45-degree field of view — 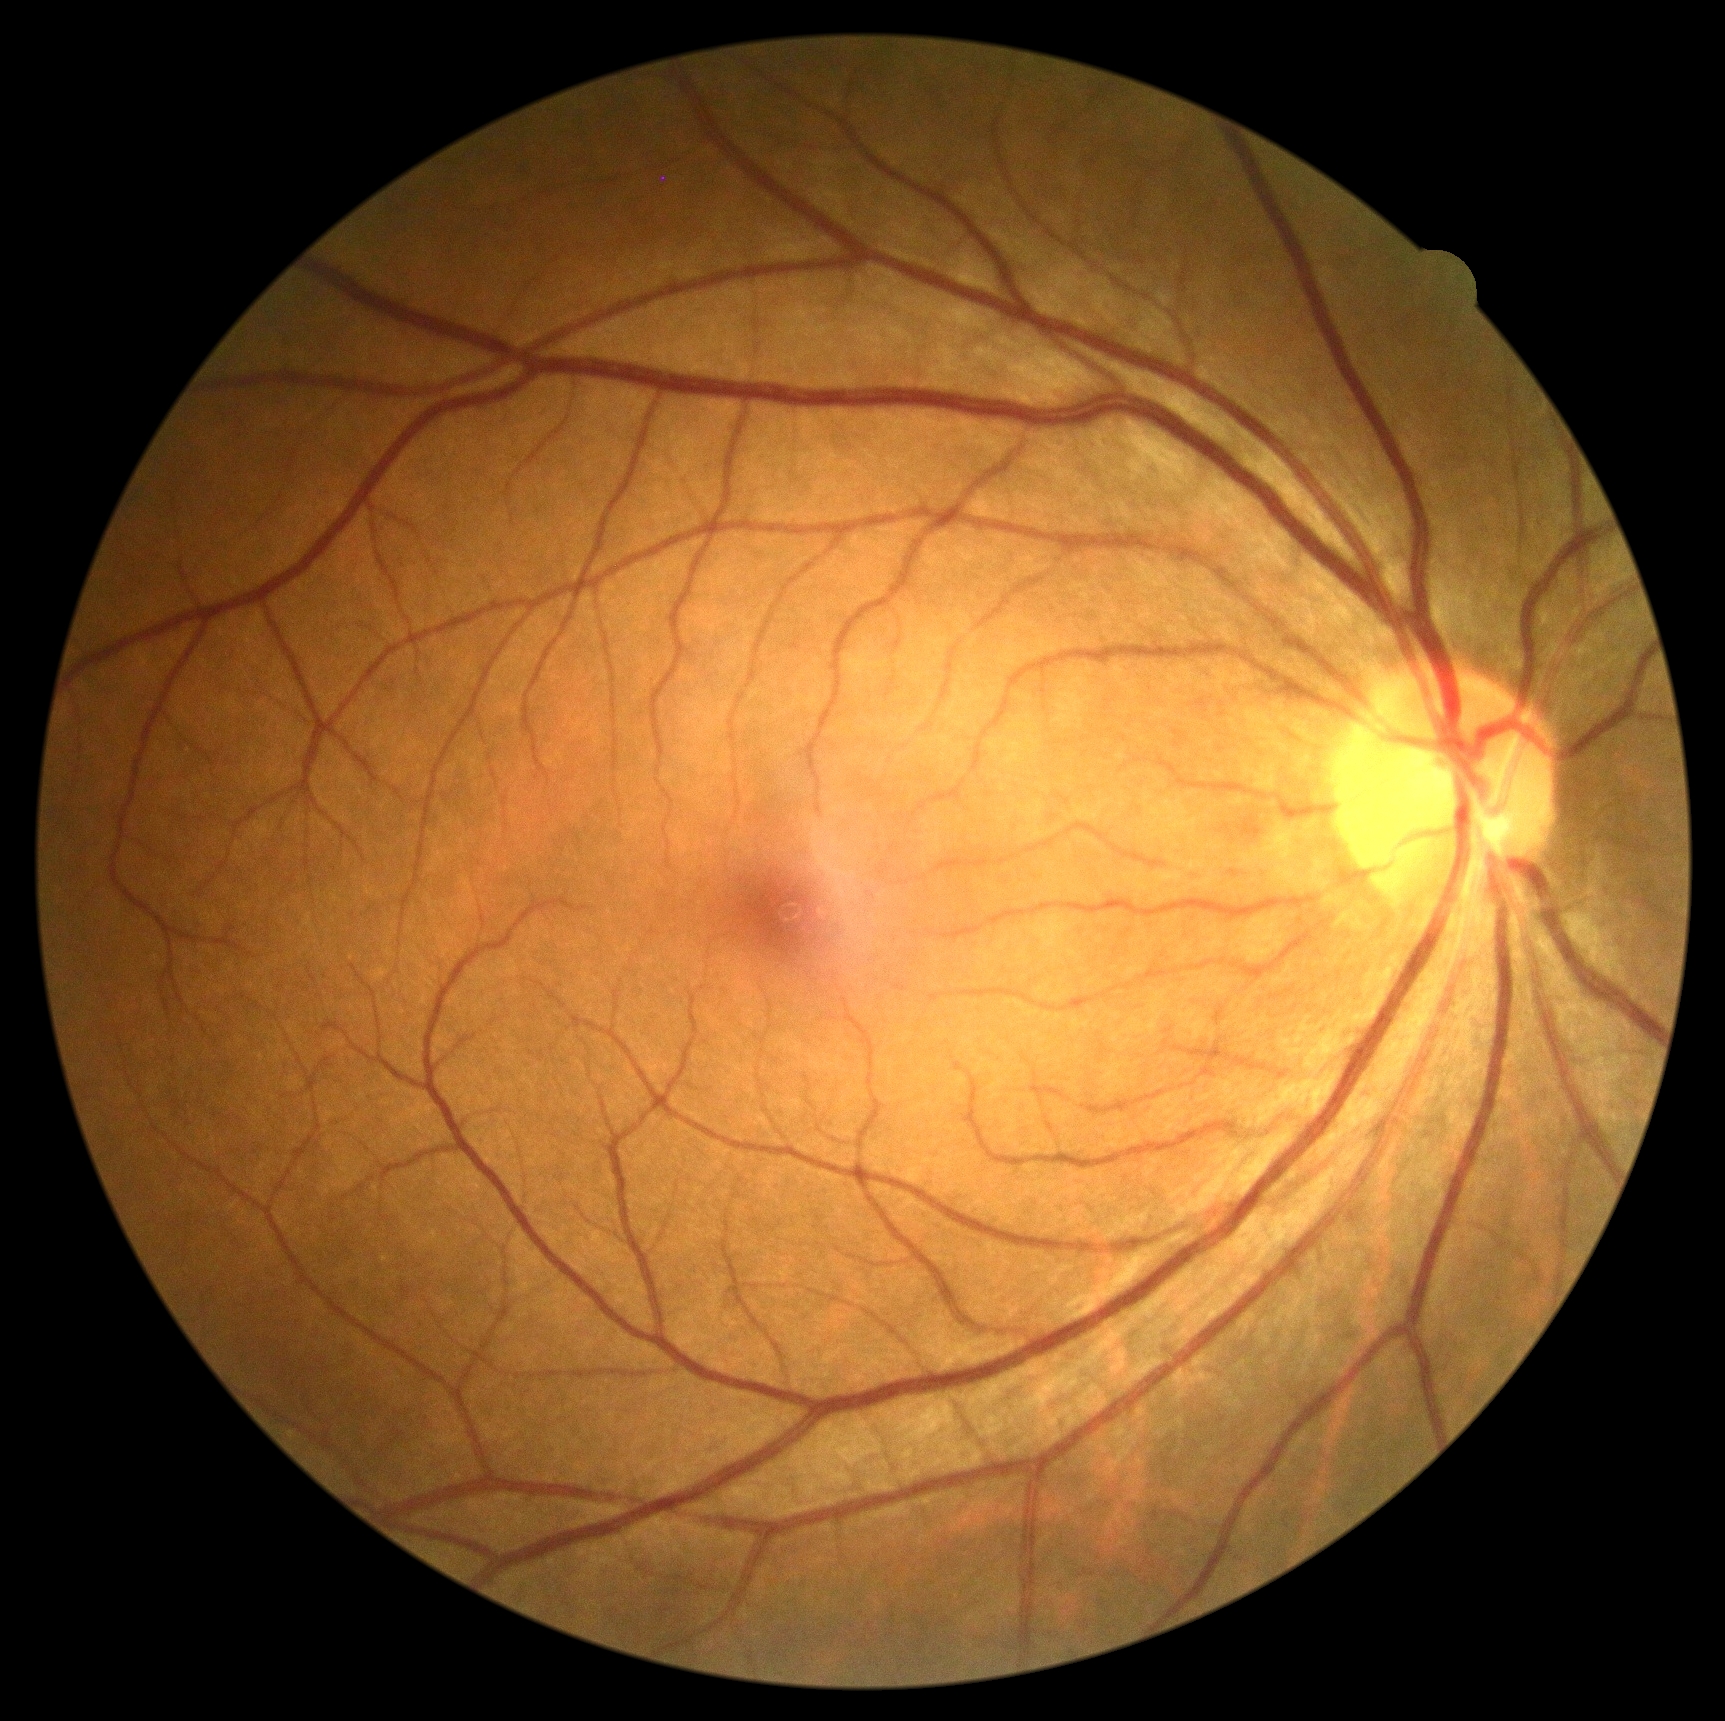
No signs of diabetic retinopathy. DR severity: no apparent diabetic retinopathy (grade 0).